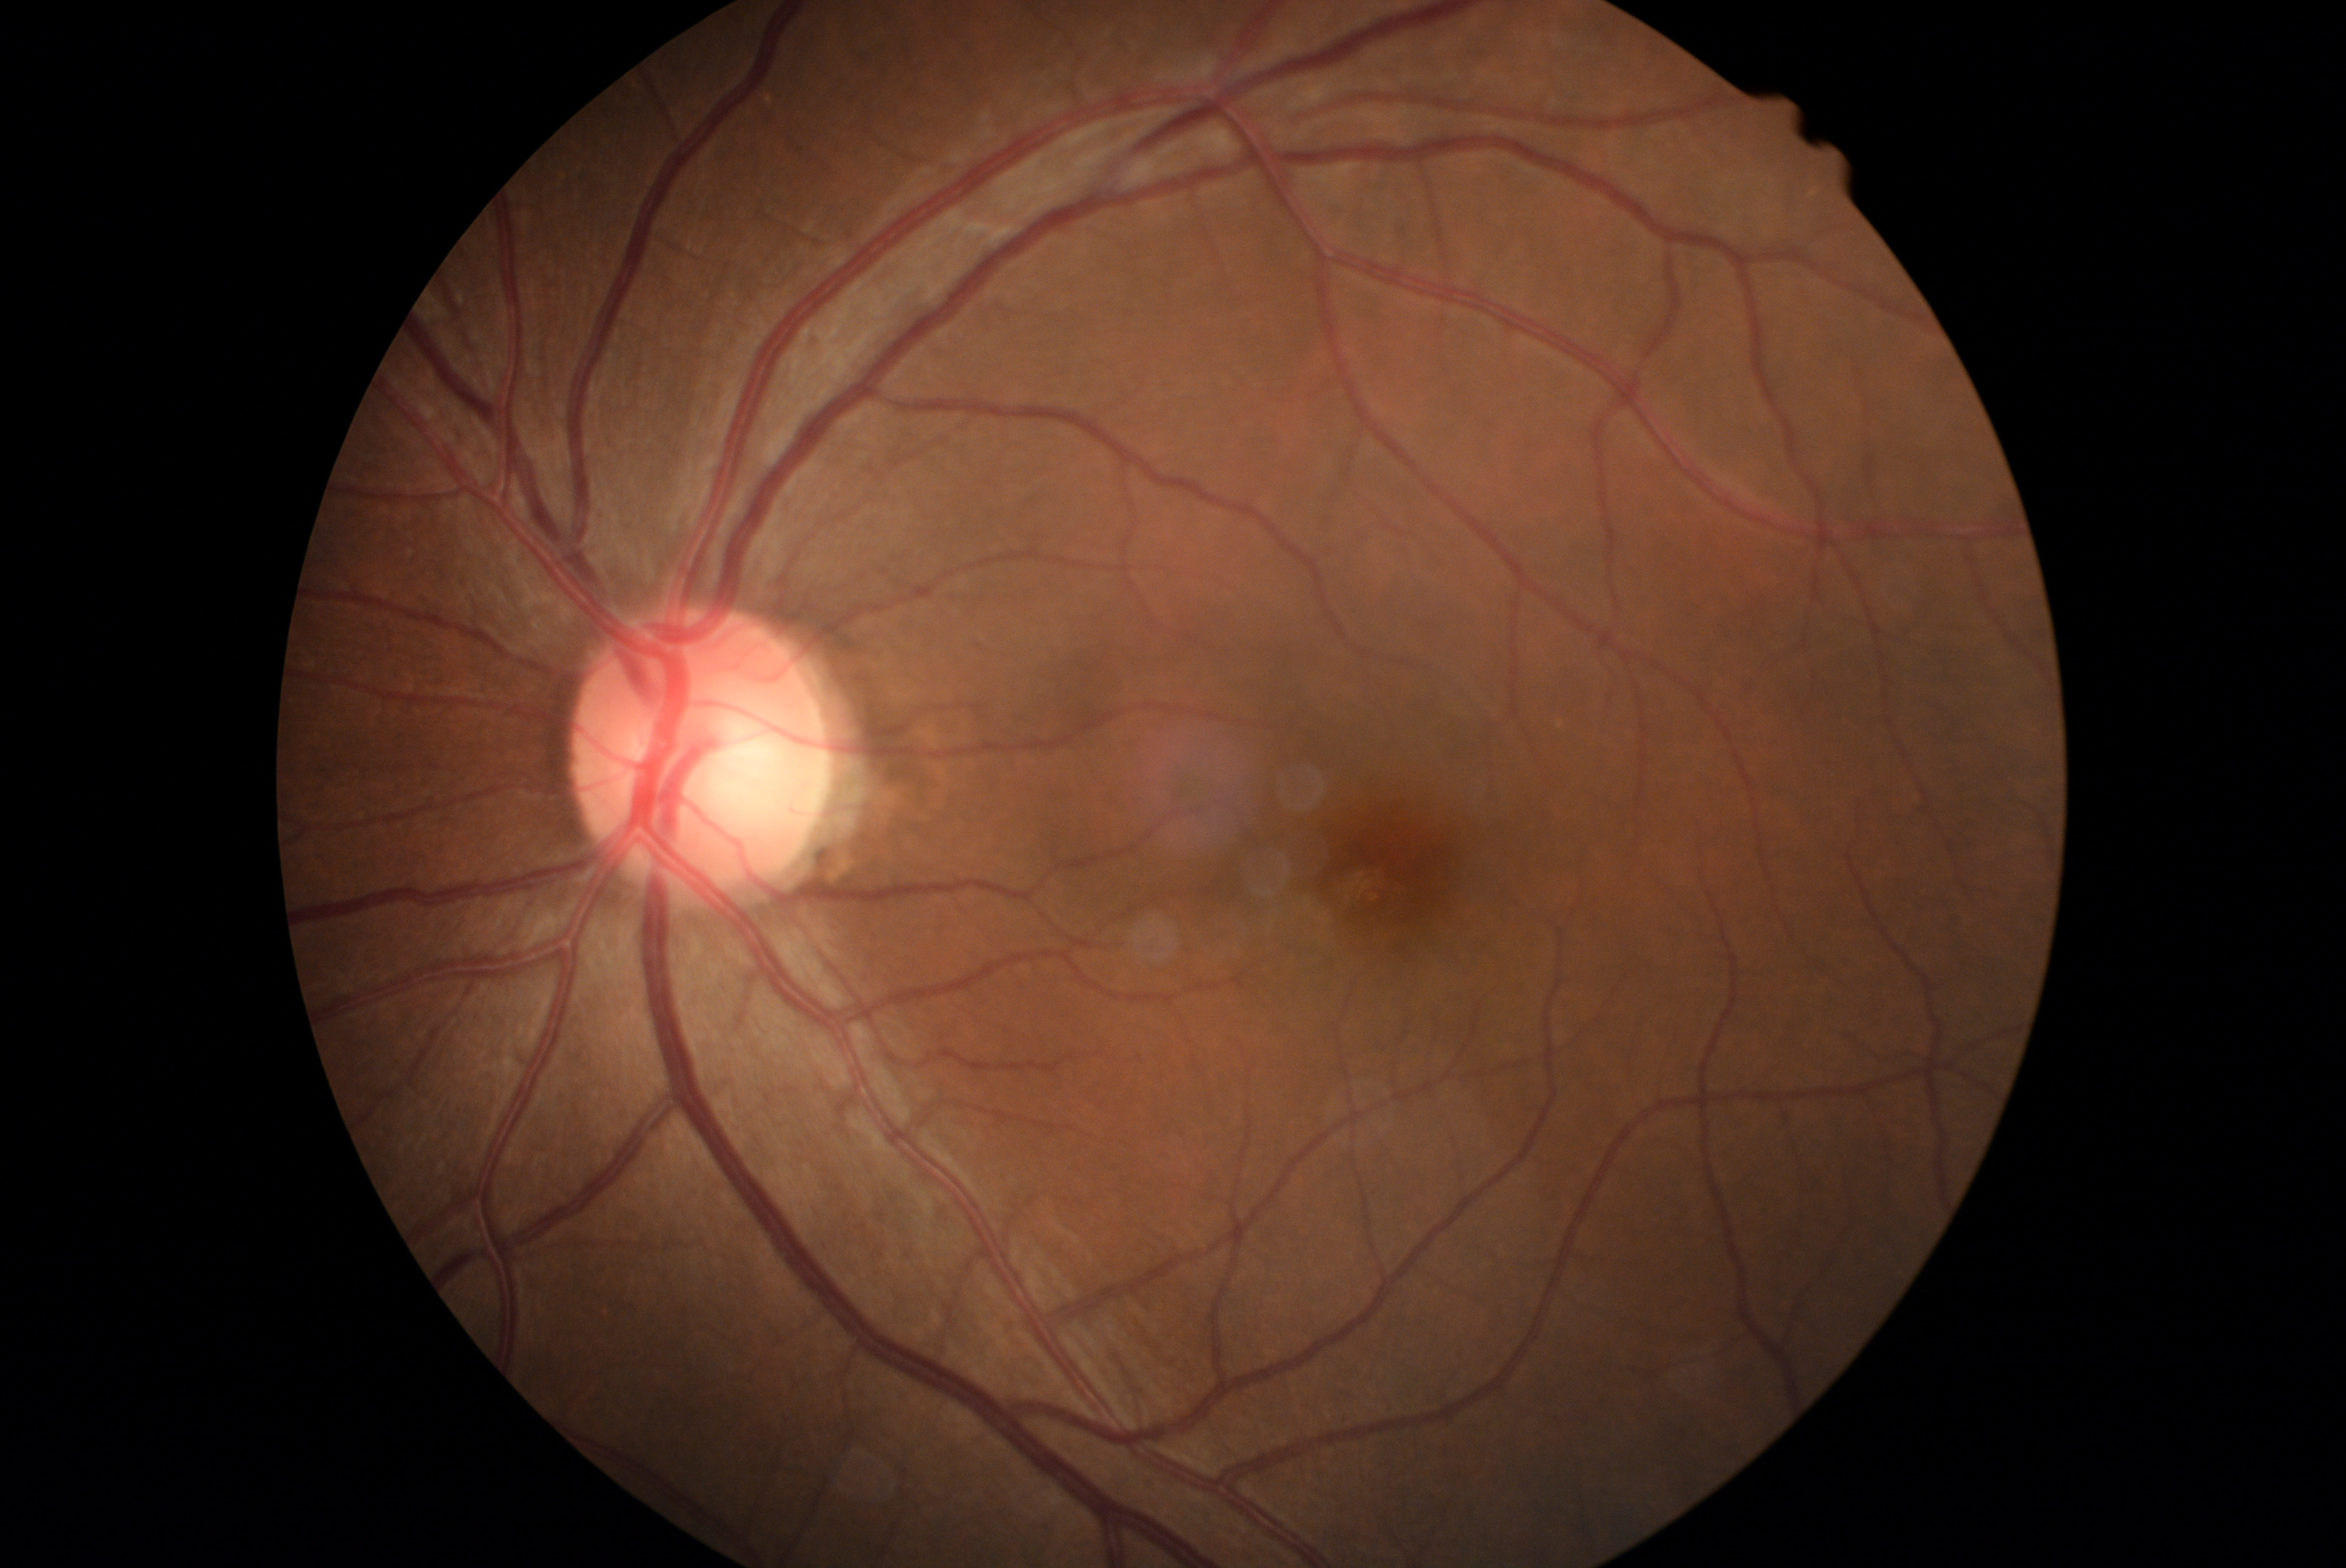

No diabetic retinal disease findings. DR grade is 0/4 — no visible signs of diabetic retinopathy.